Wide-field fundus photograph of an infant · 1240x1240px:
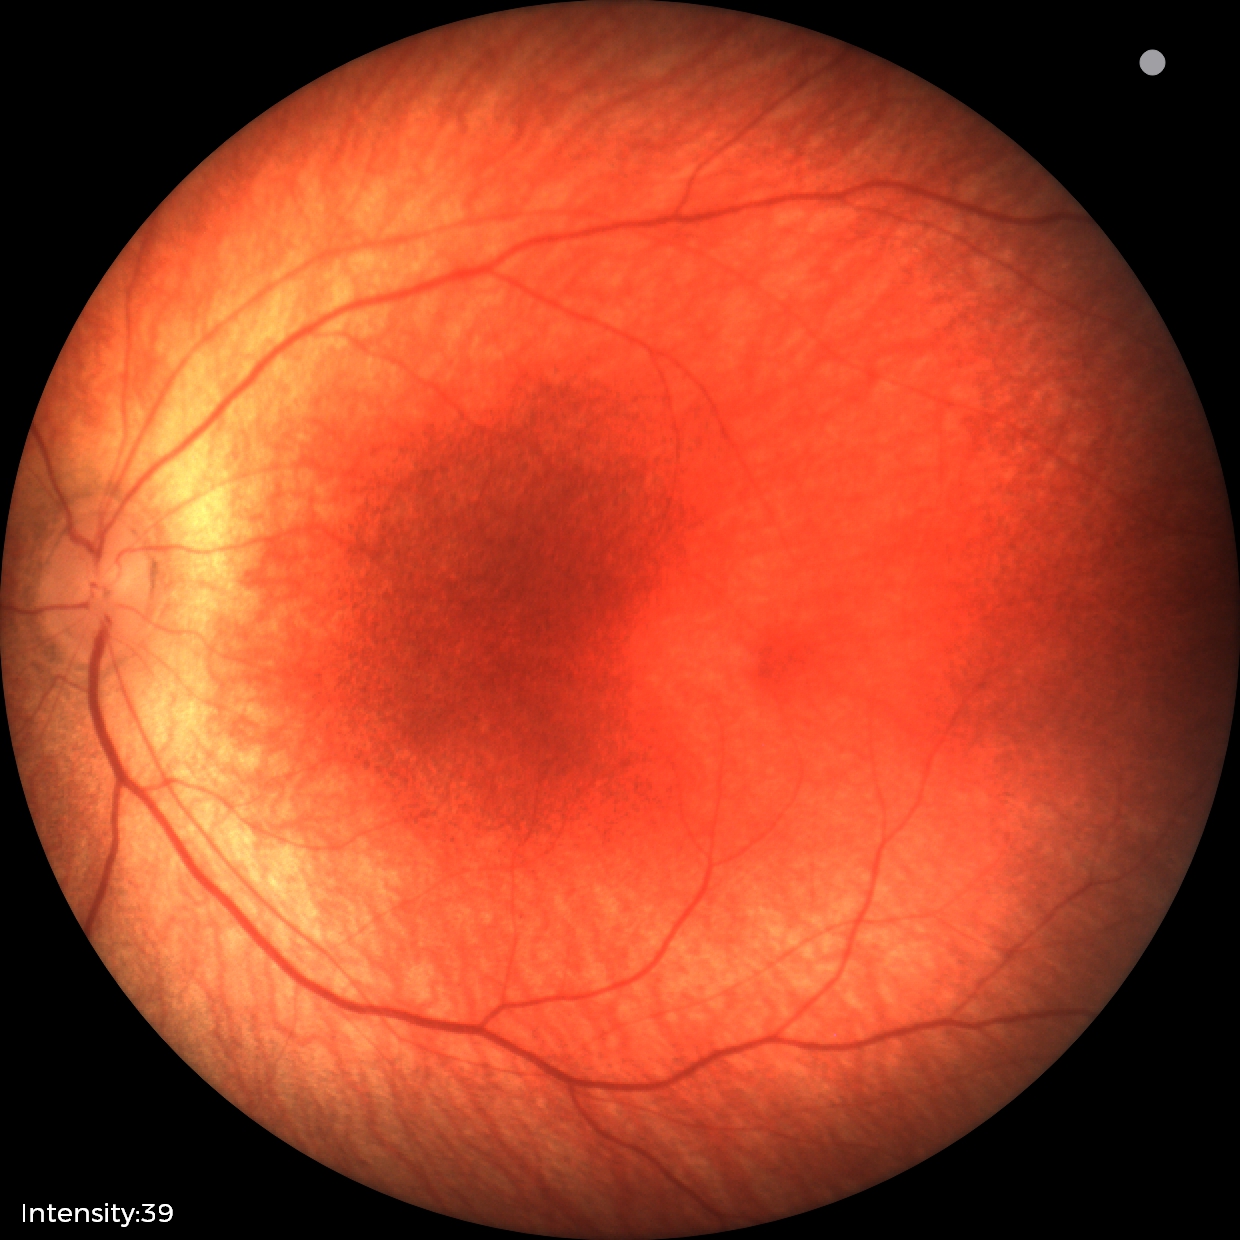
Q: What is the diagnosis from this examination?
A: physiological retinal finding